Pediatric wide-field fundus photograph · 640 by 480 pixels.
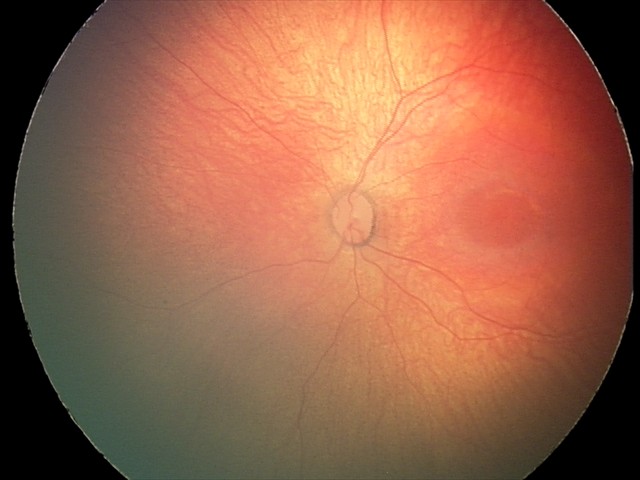 Assessment: normal retinal appearance.